Color fundus photograph: 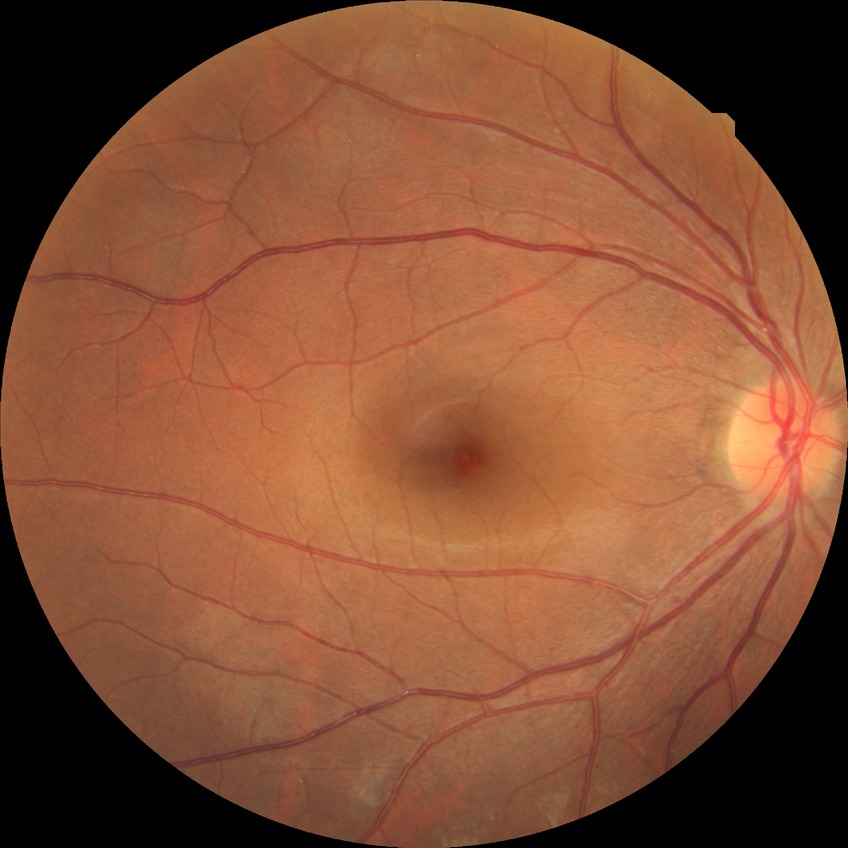

{
  "davis_grade": "no diabetic retinopathy"
}